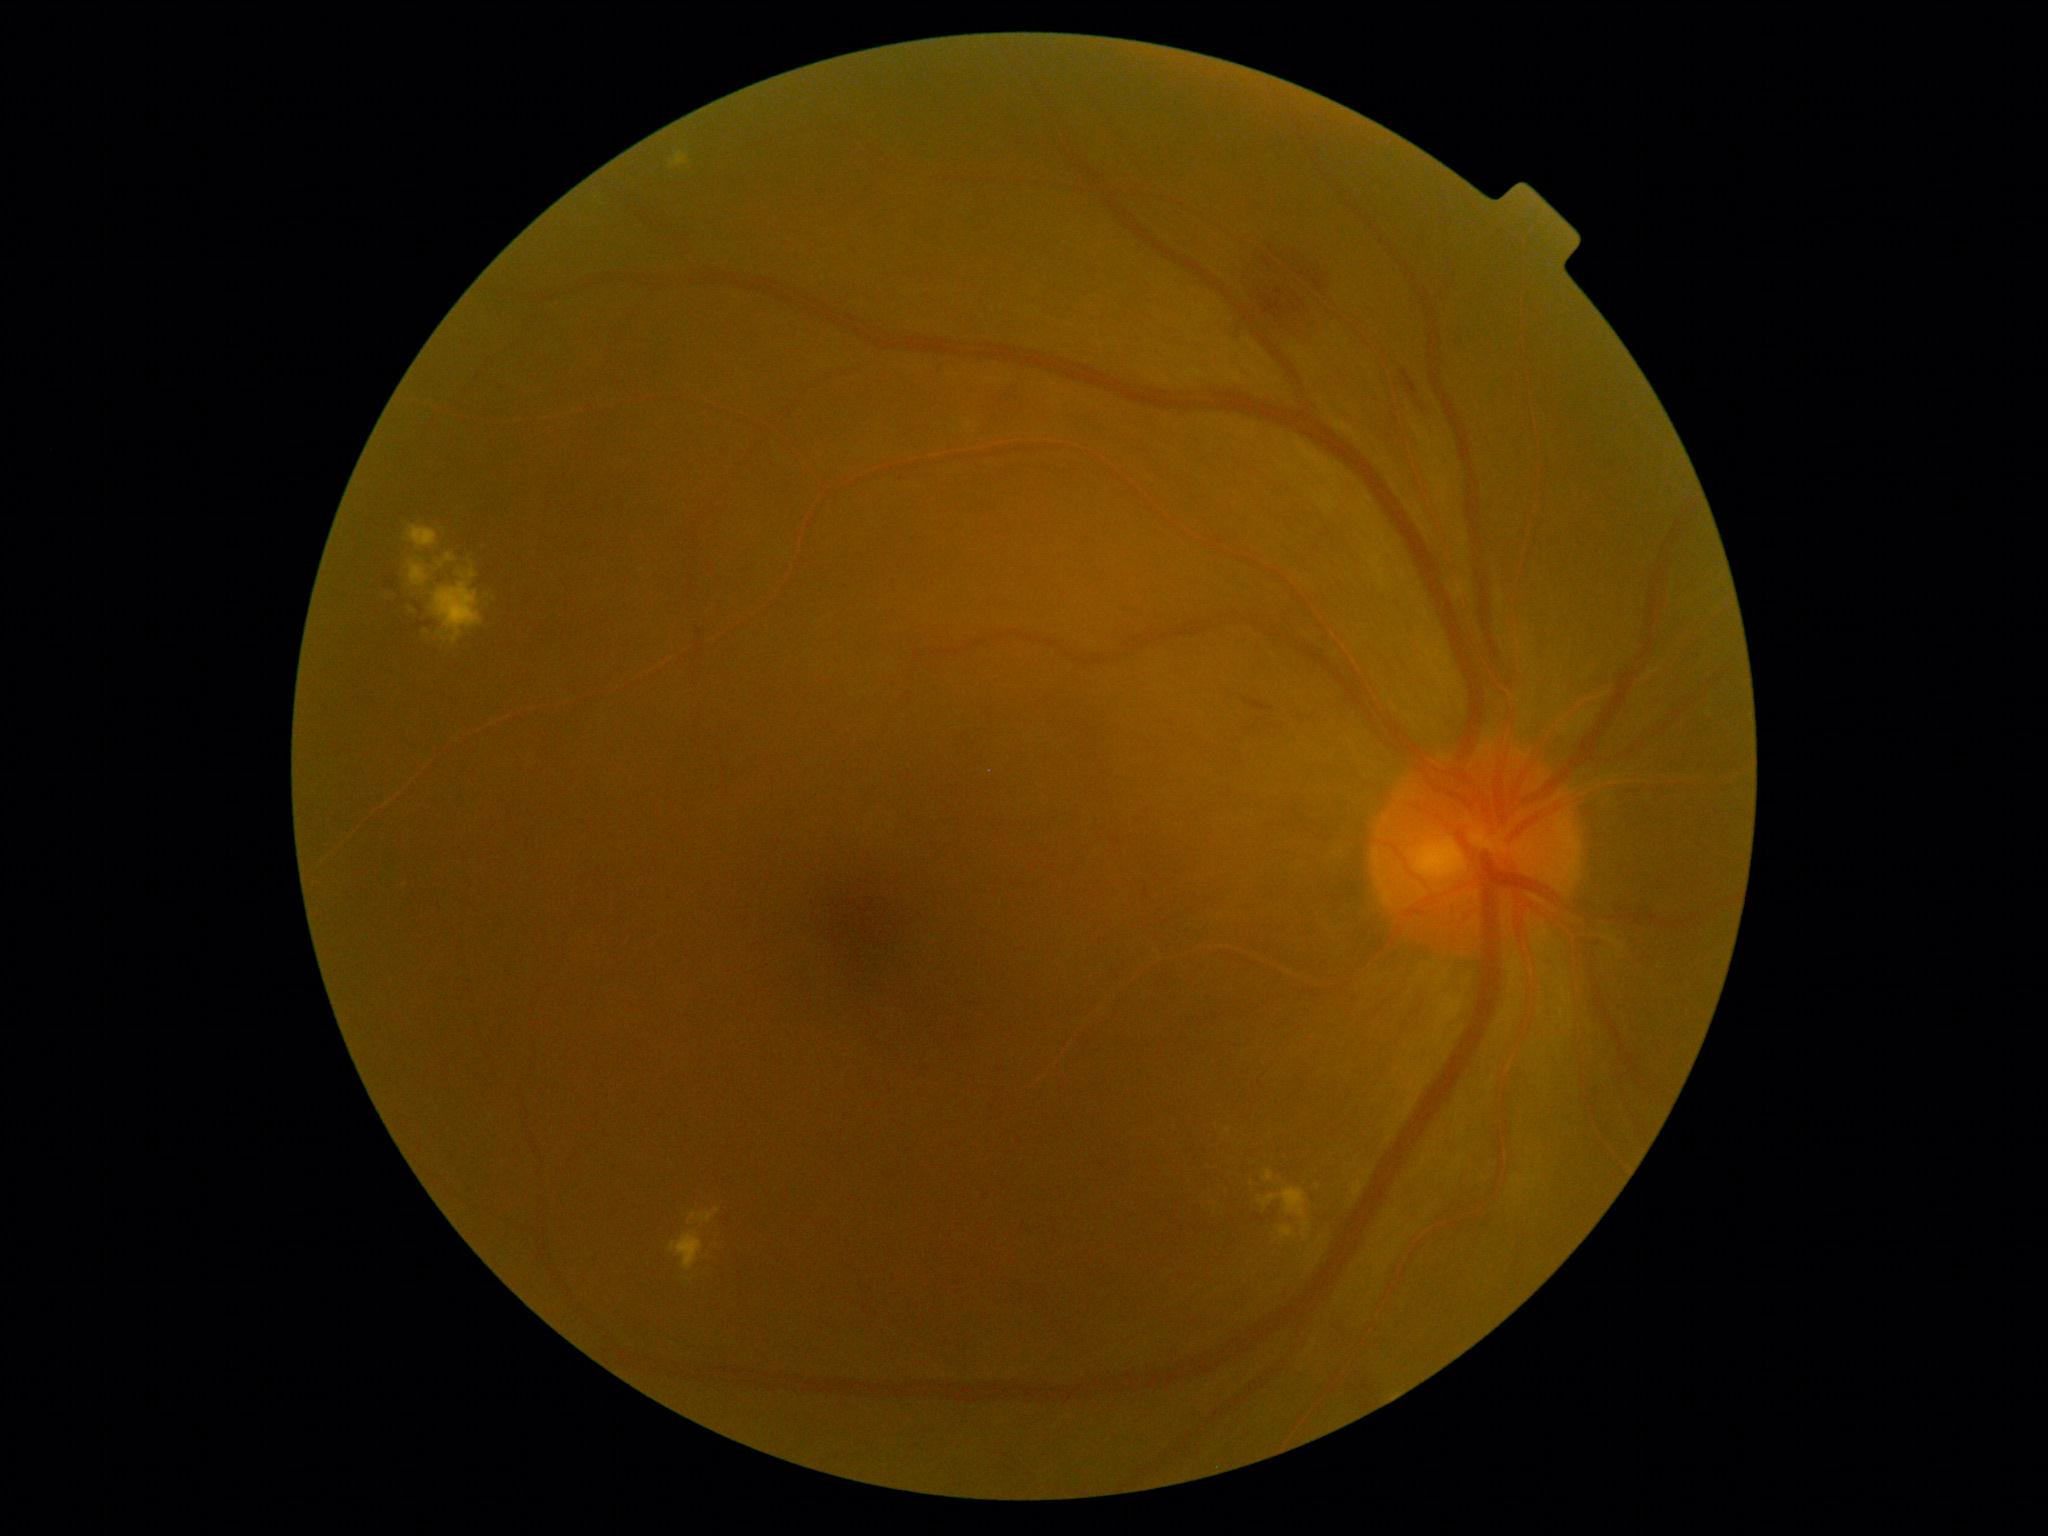

{"dr_grade": 2, "dr_grade_name": "moderate NPDR", "lesions": {"he": [[1228, 245, 1332, 340], [390, 577, 399, 582], [1251, 701, 1272, 712], [1398, 359, 1437, 435], [386, 578, 397, 590], [419, 623, 432, 627]], "he_small_approx": [[420, 610]], "ma": null, "ex": [[1259, 1188, 1307, 1218], [439, 554, 457, 568], [1265, 1171, 1274, 1182], [671, 152, 688, 168], [1281, 1227, 1294, 1239], [409, 526, 437, 551], [670, 1232, 704, 1273], [688, 1209, 720, 1227], [377, 588, 403, 598], [1302, 1224, 1311, 1239], [459, 552, 477, 580], [410, 564, 483, 644], [424, 628, 446, 641]], "ex_small_approx": [[1229, 1131]], "se": null}}